FOV: 45 degrees · fundus photo:
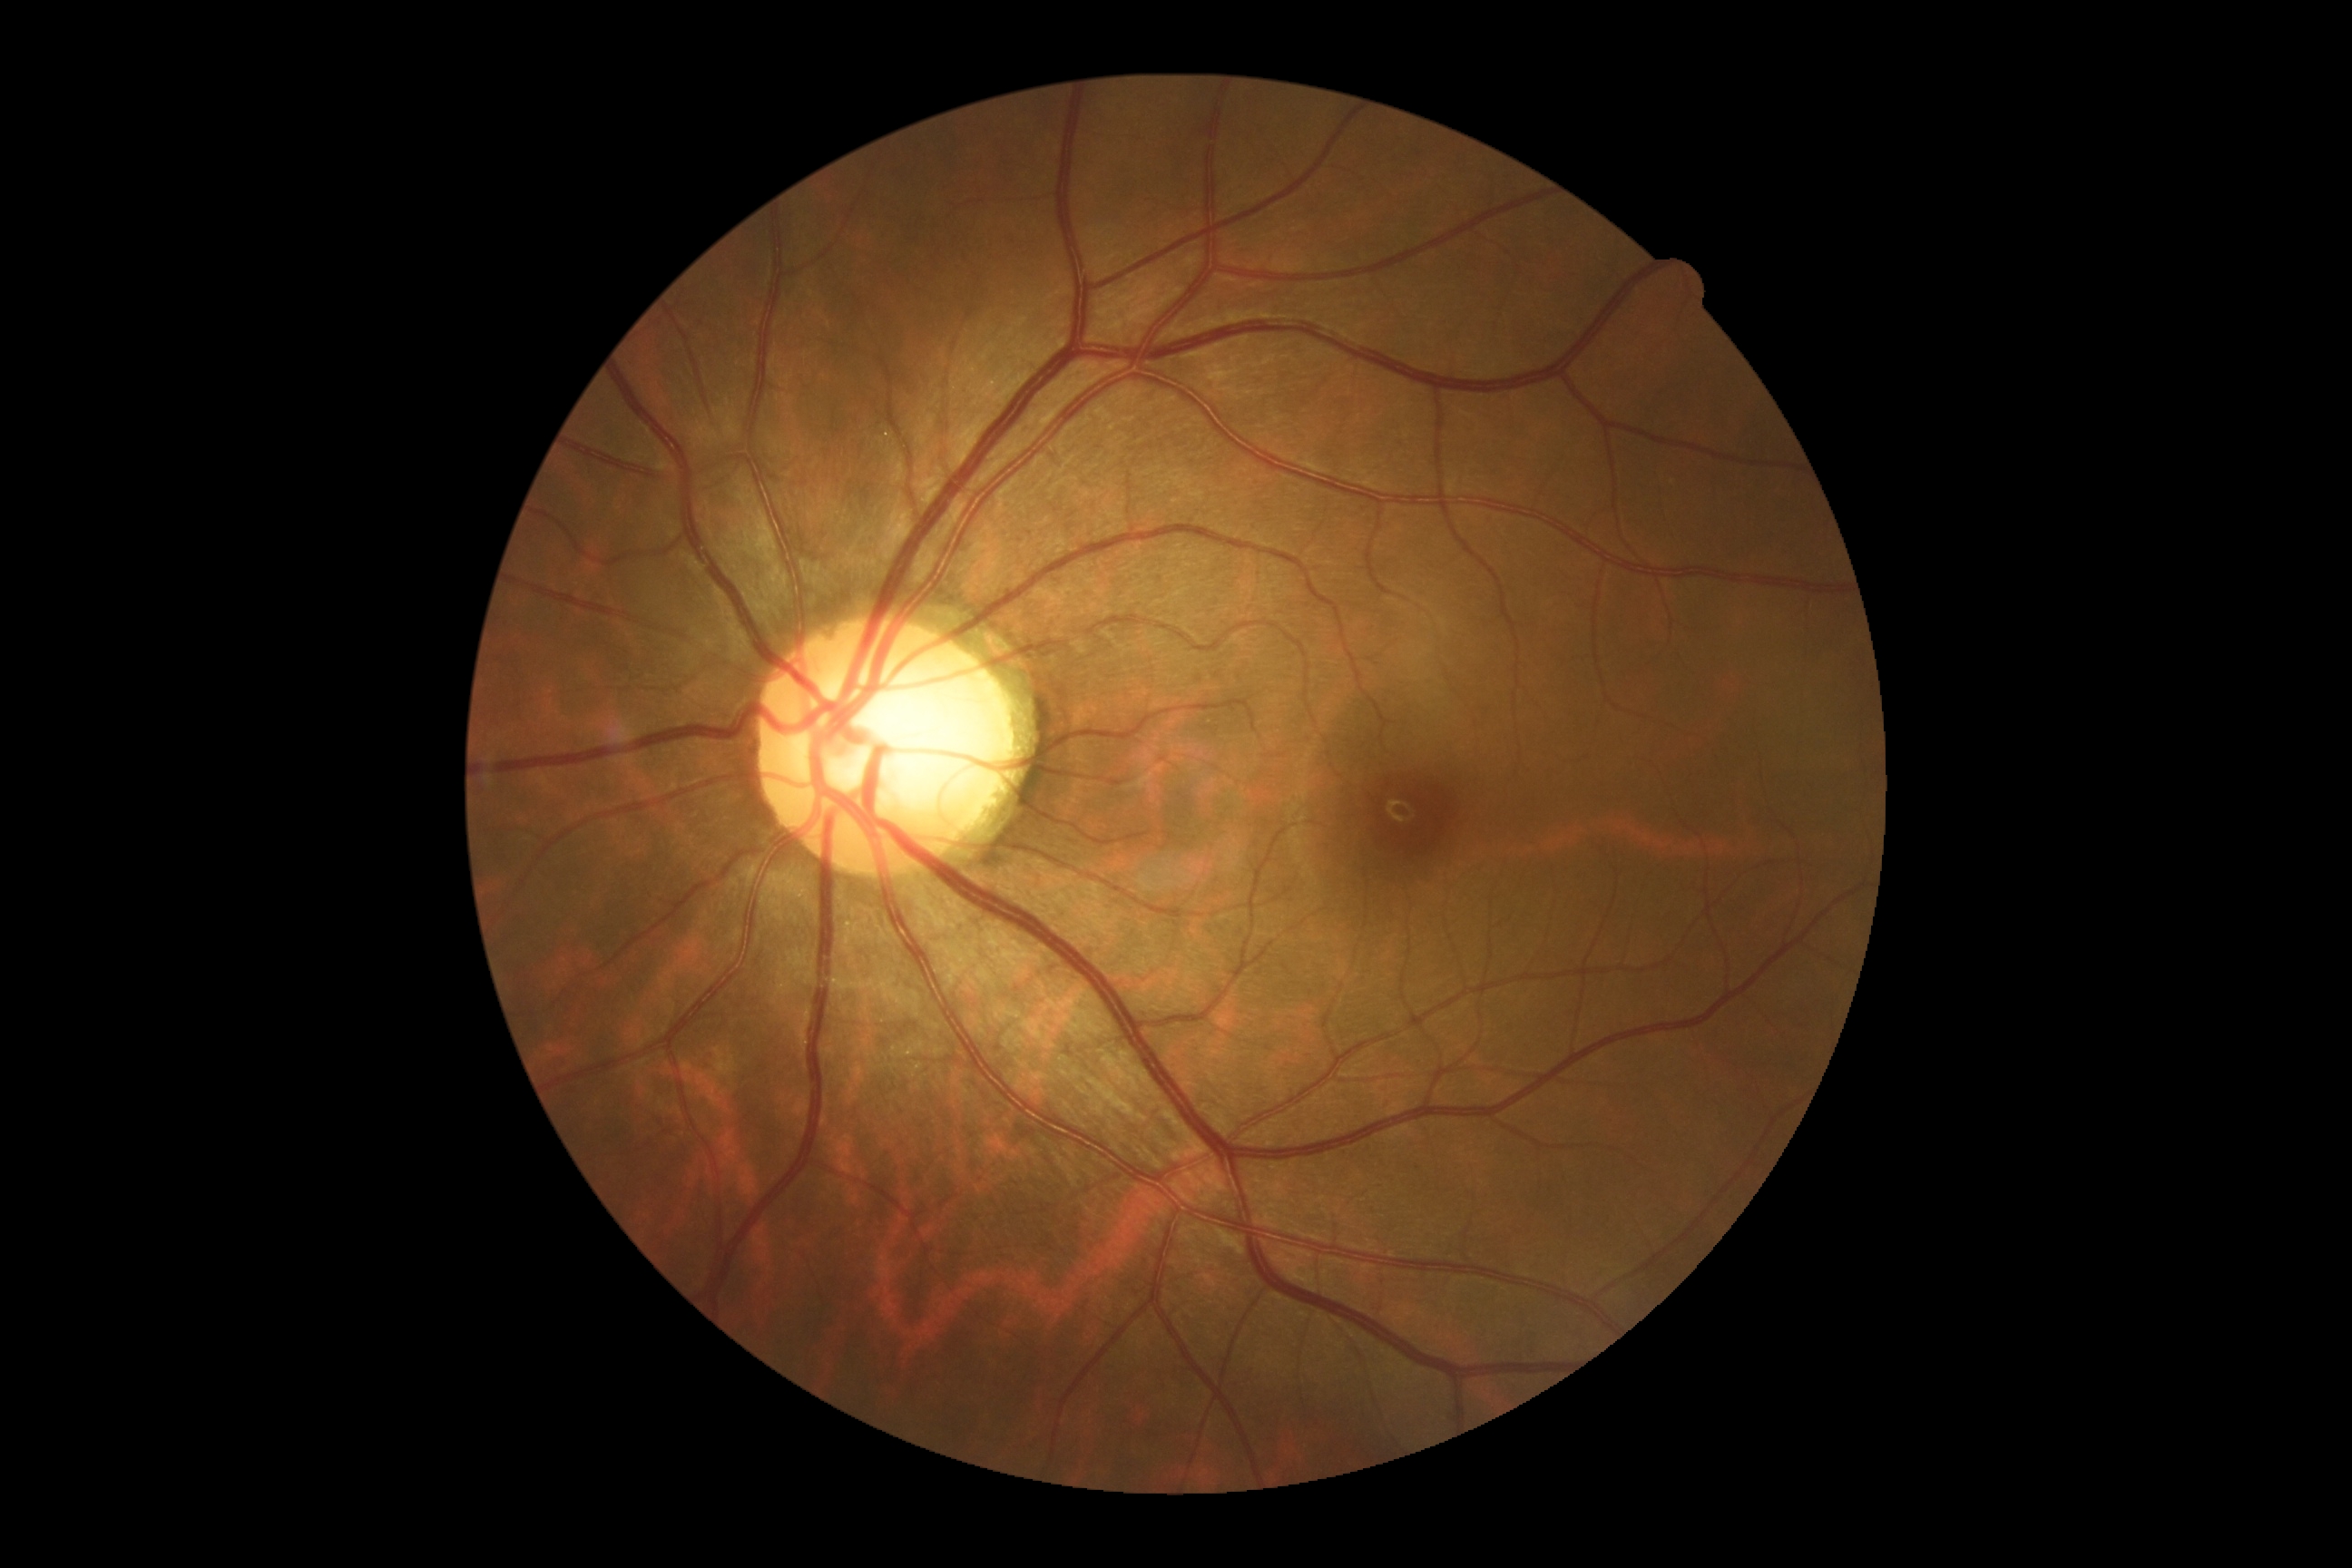

No diabetic retinal disease findings.
Diabetic retinopathy severity is 0/4.